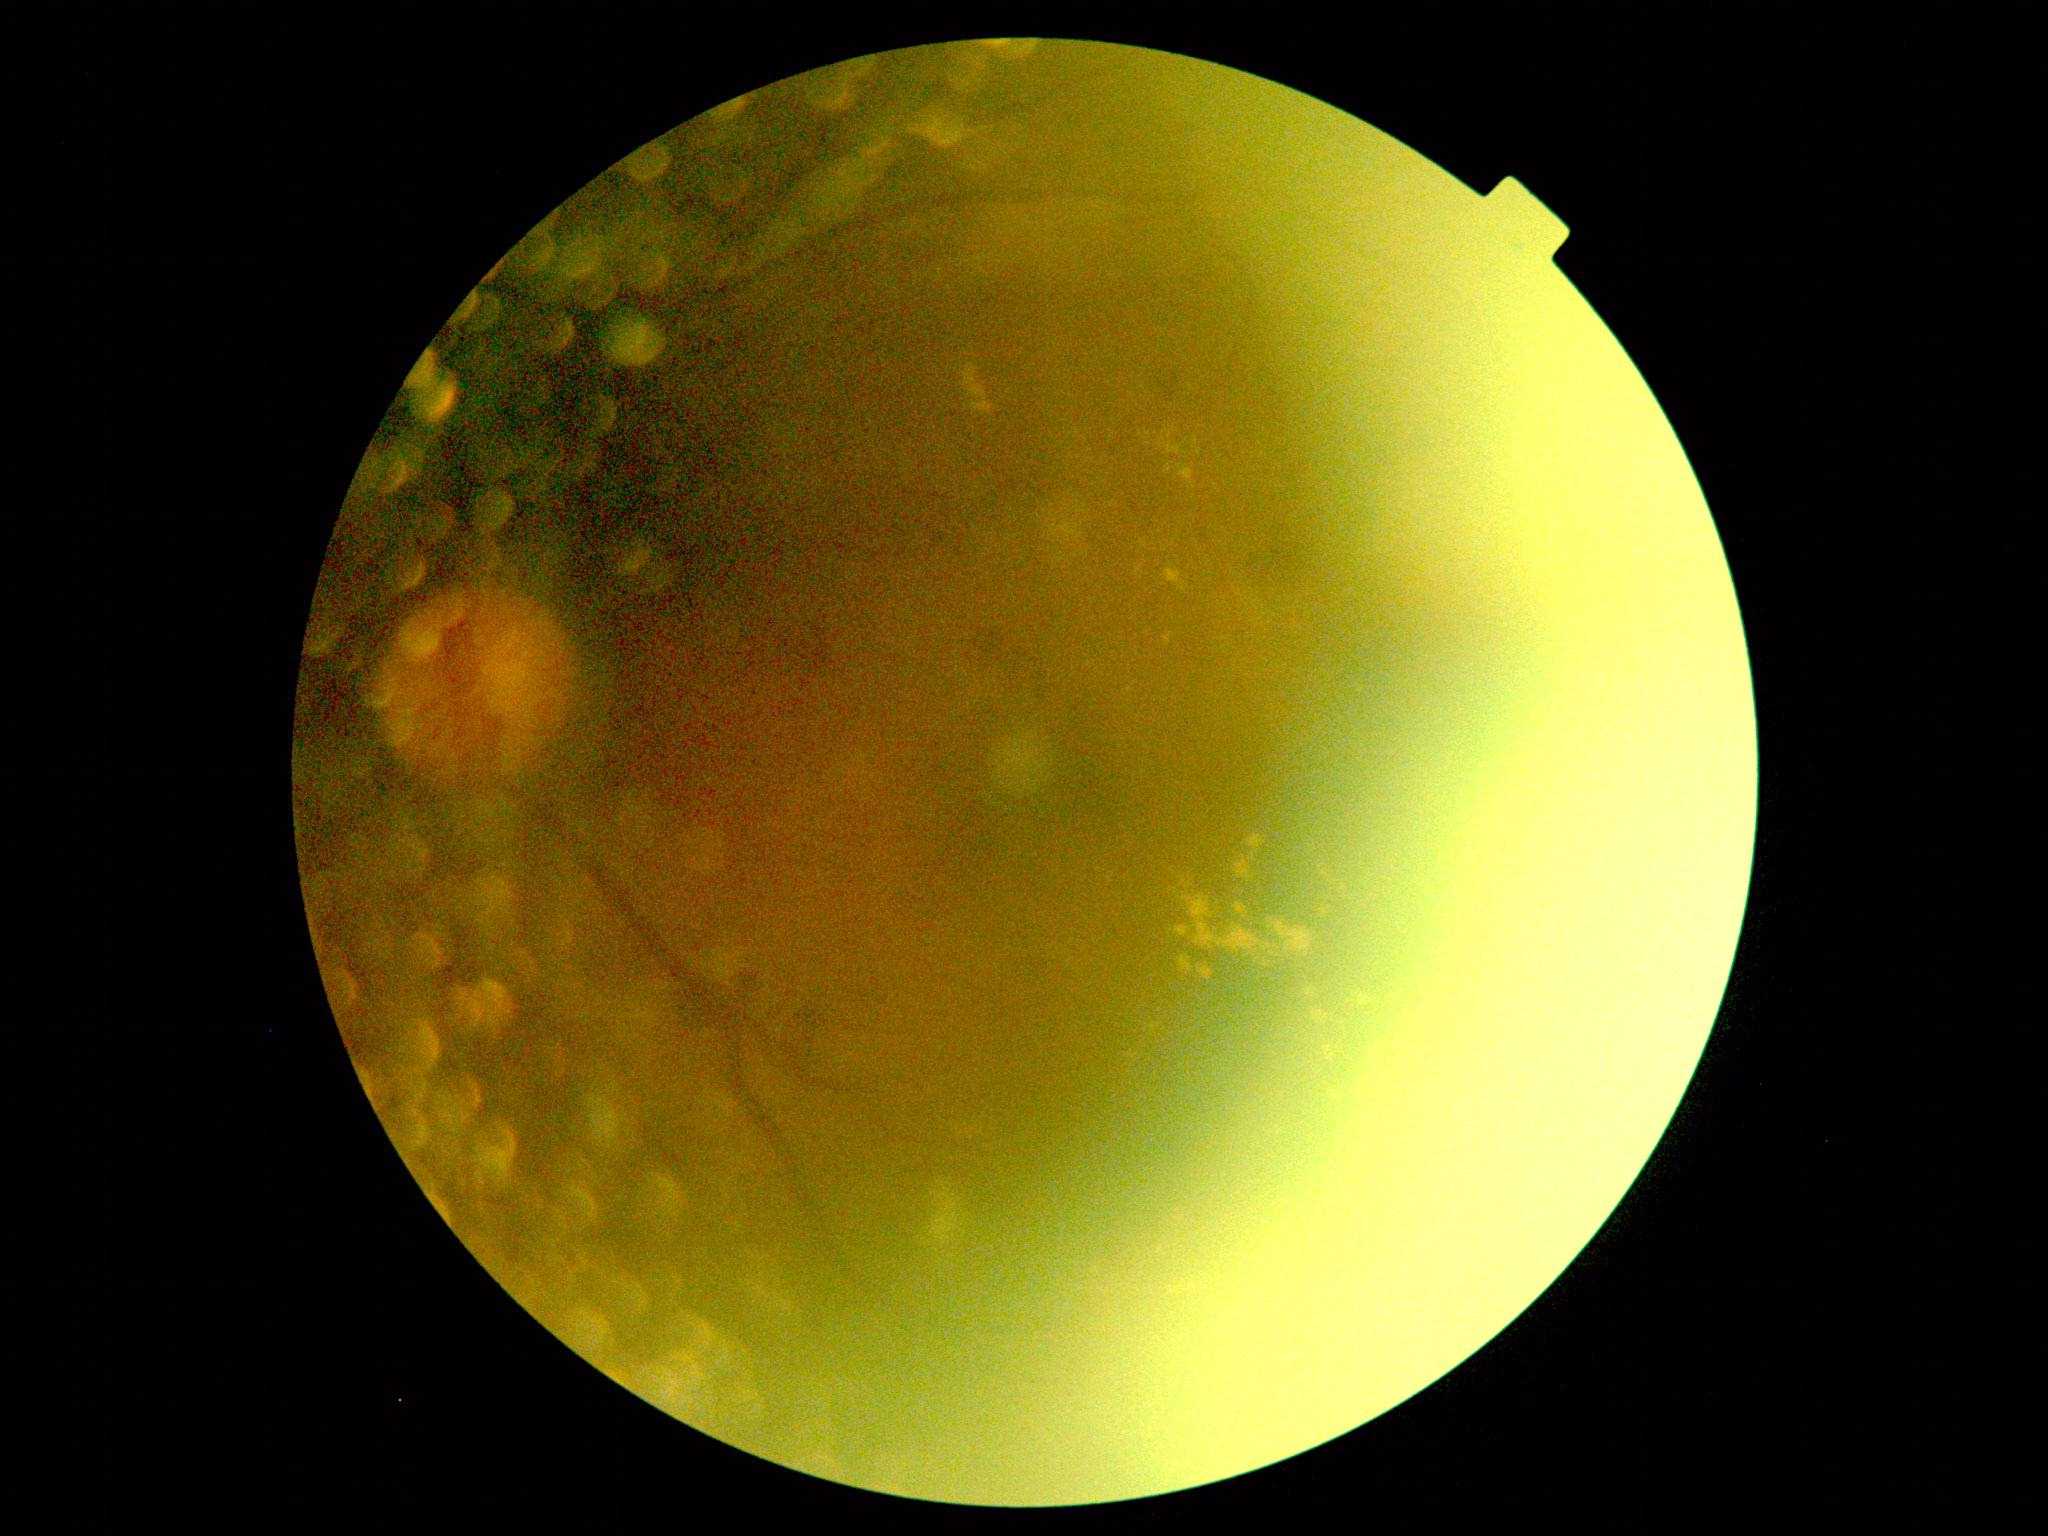

DR stage: grade 2.